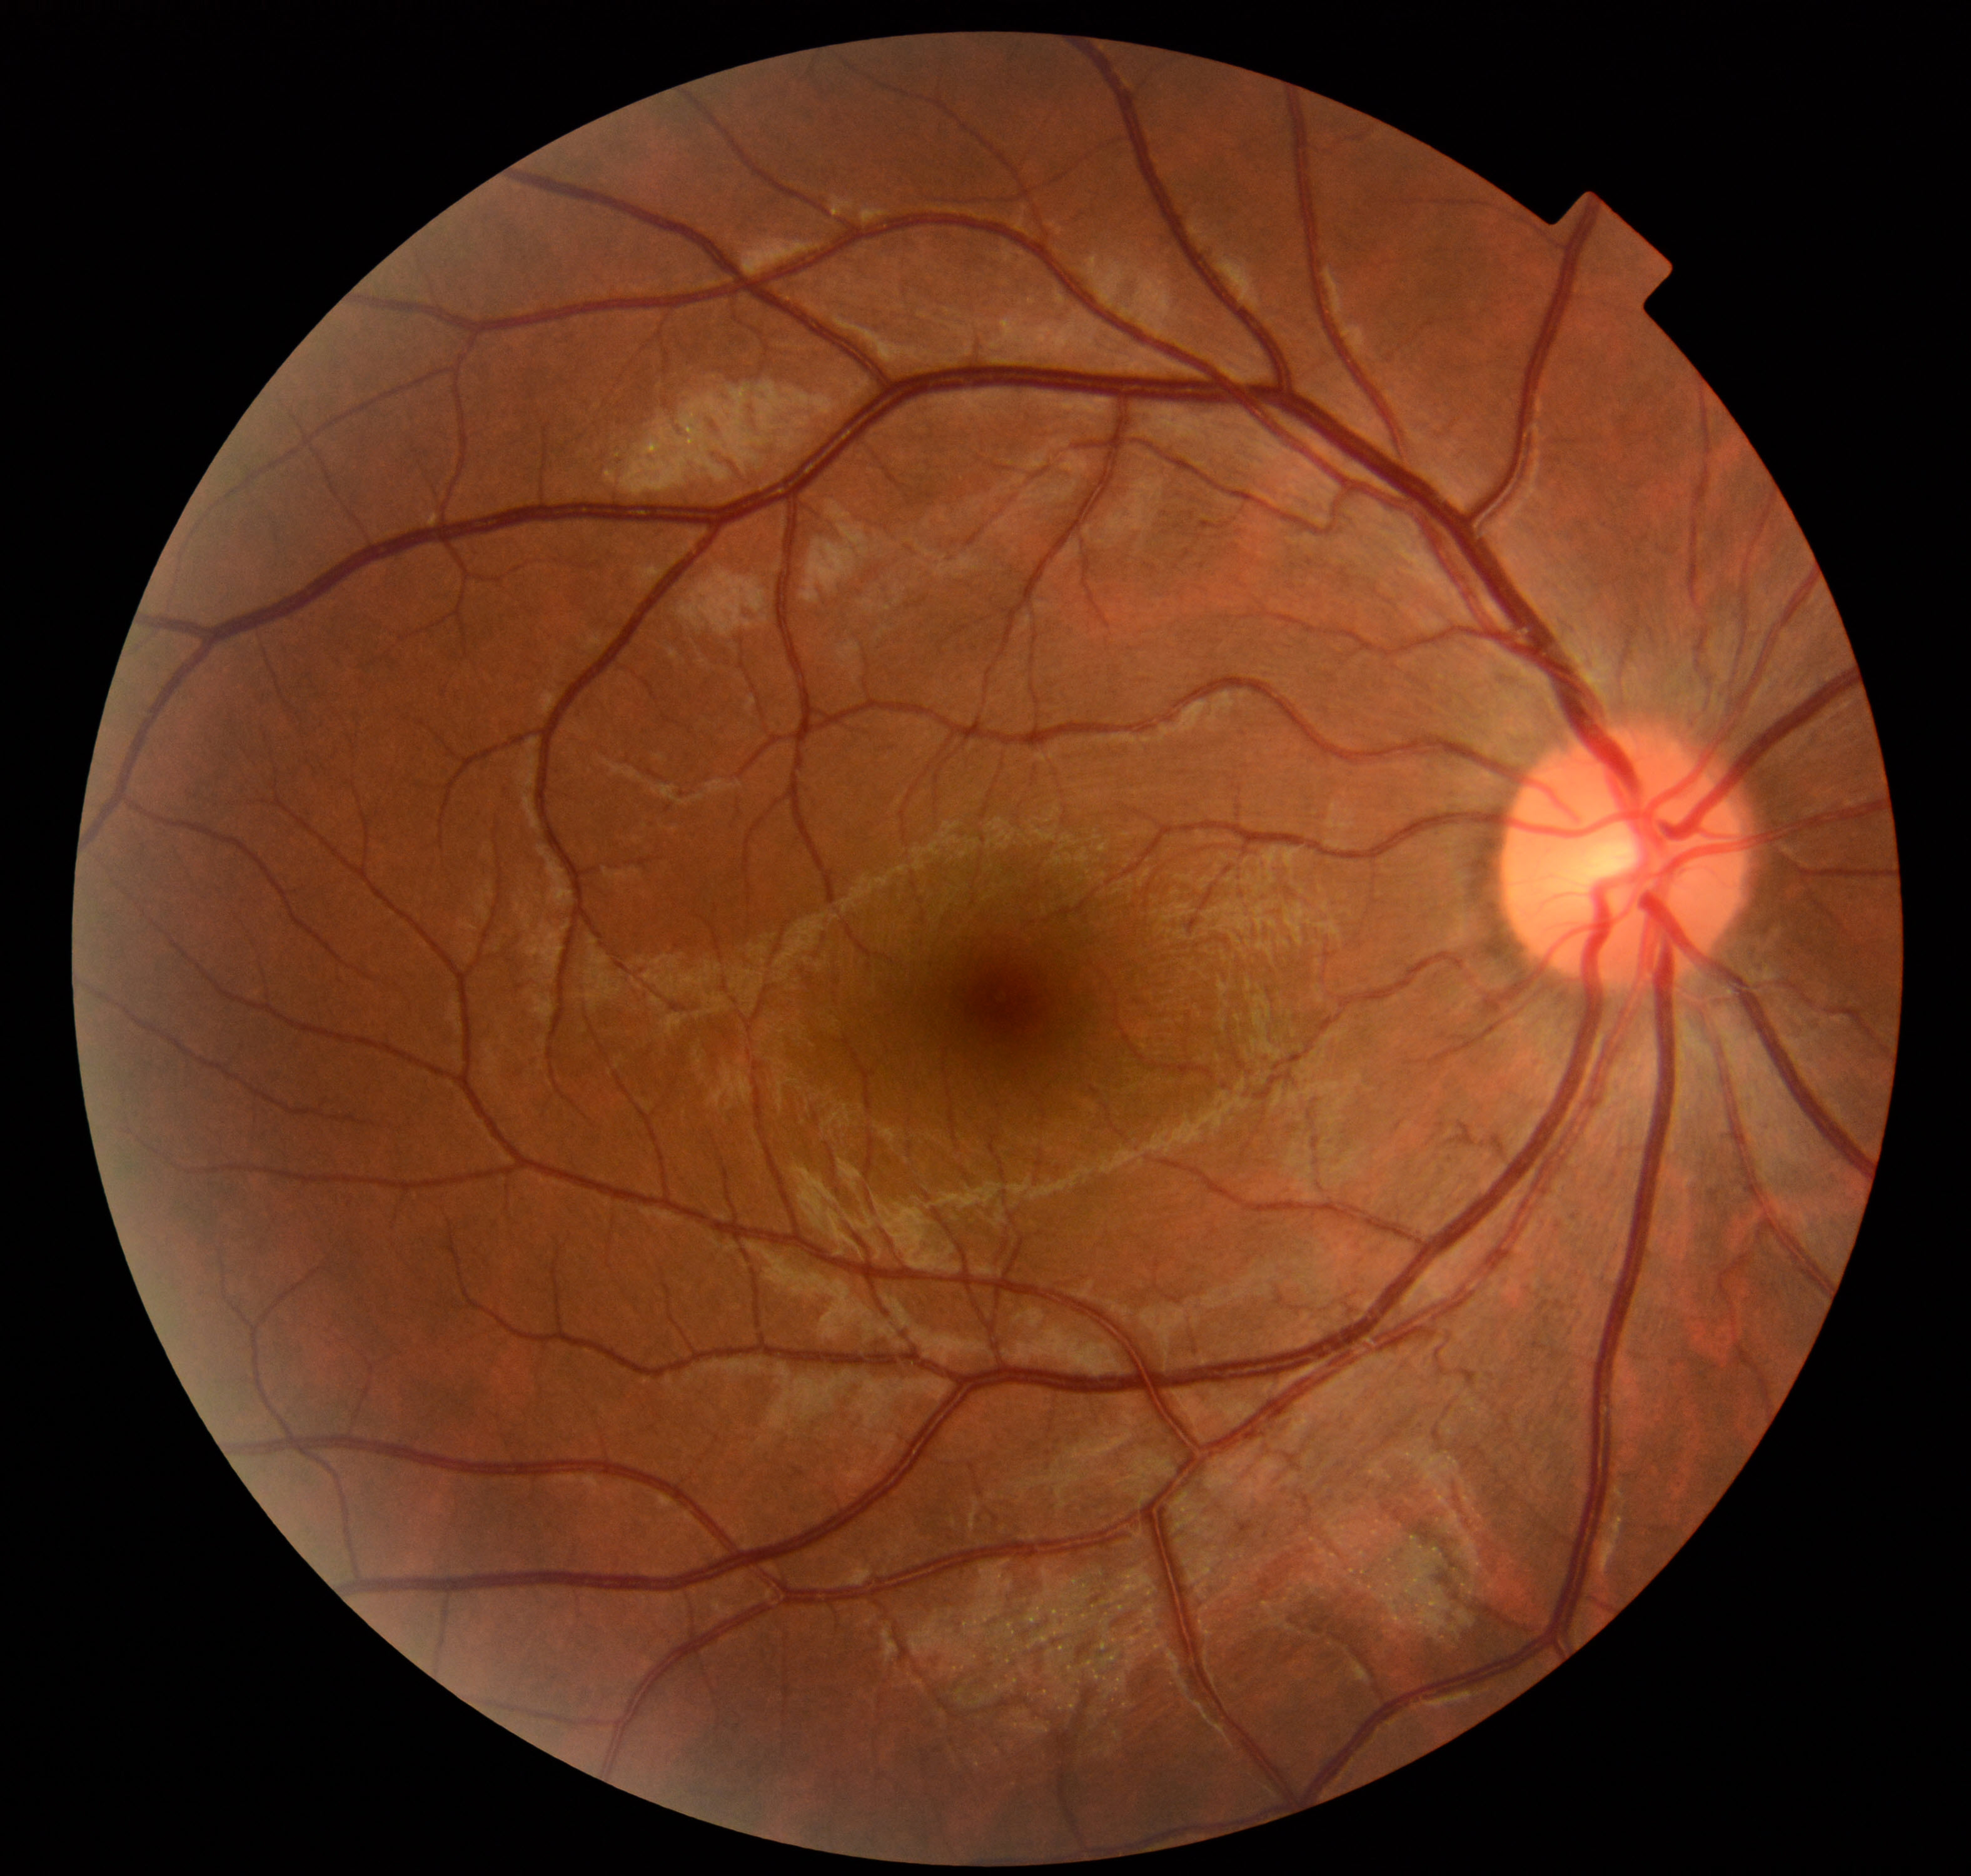
Normal fundus. No pathology identified.